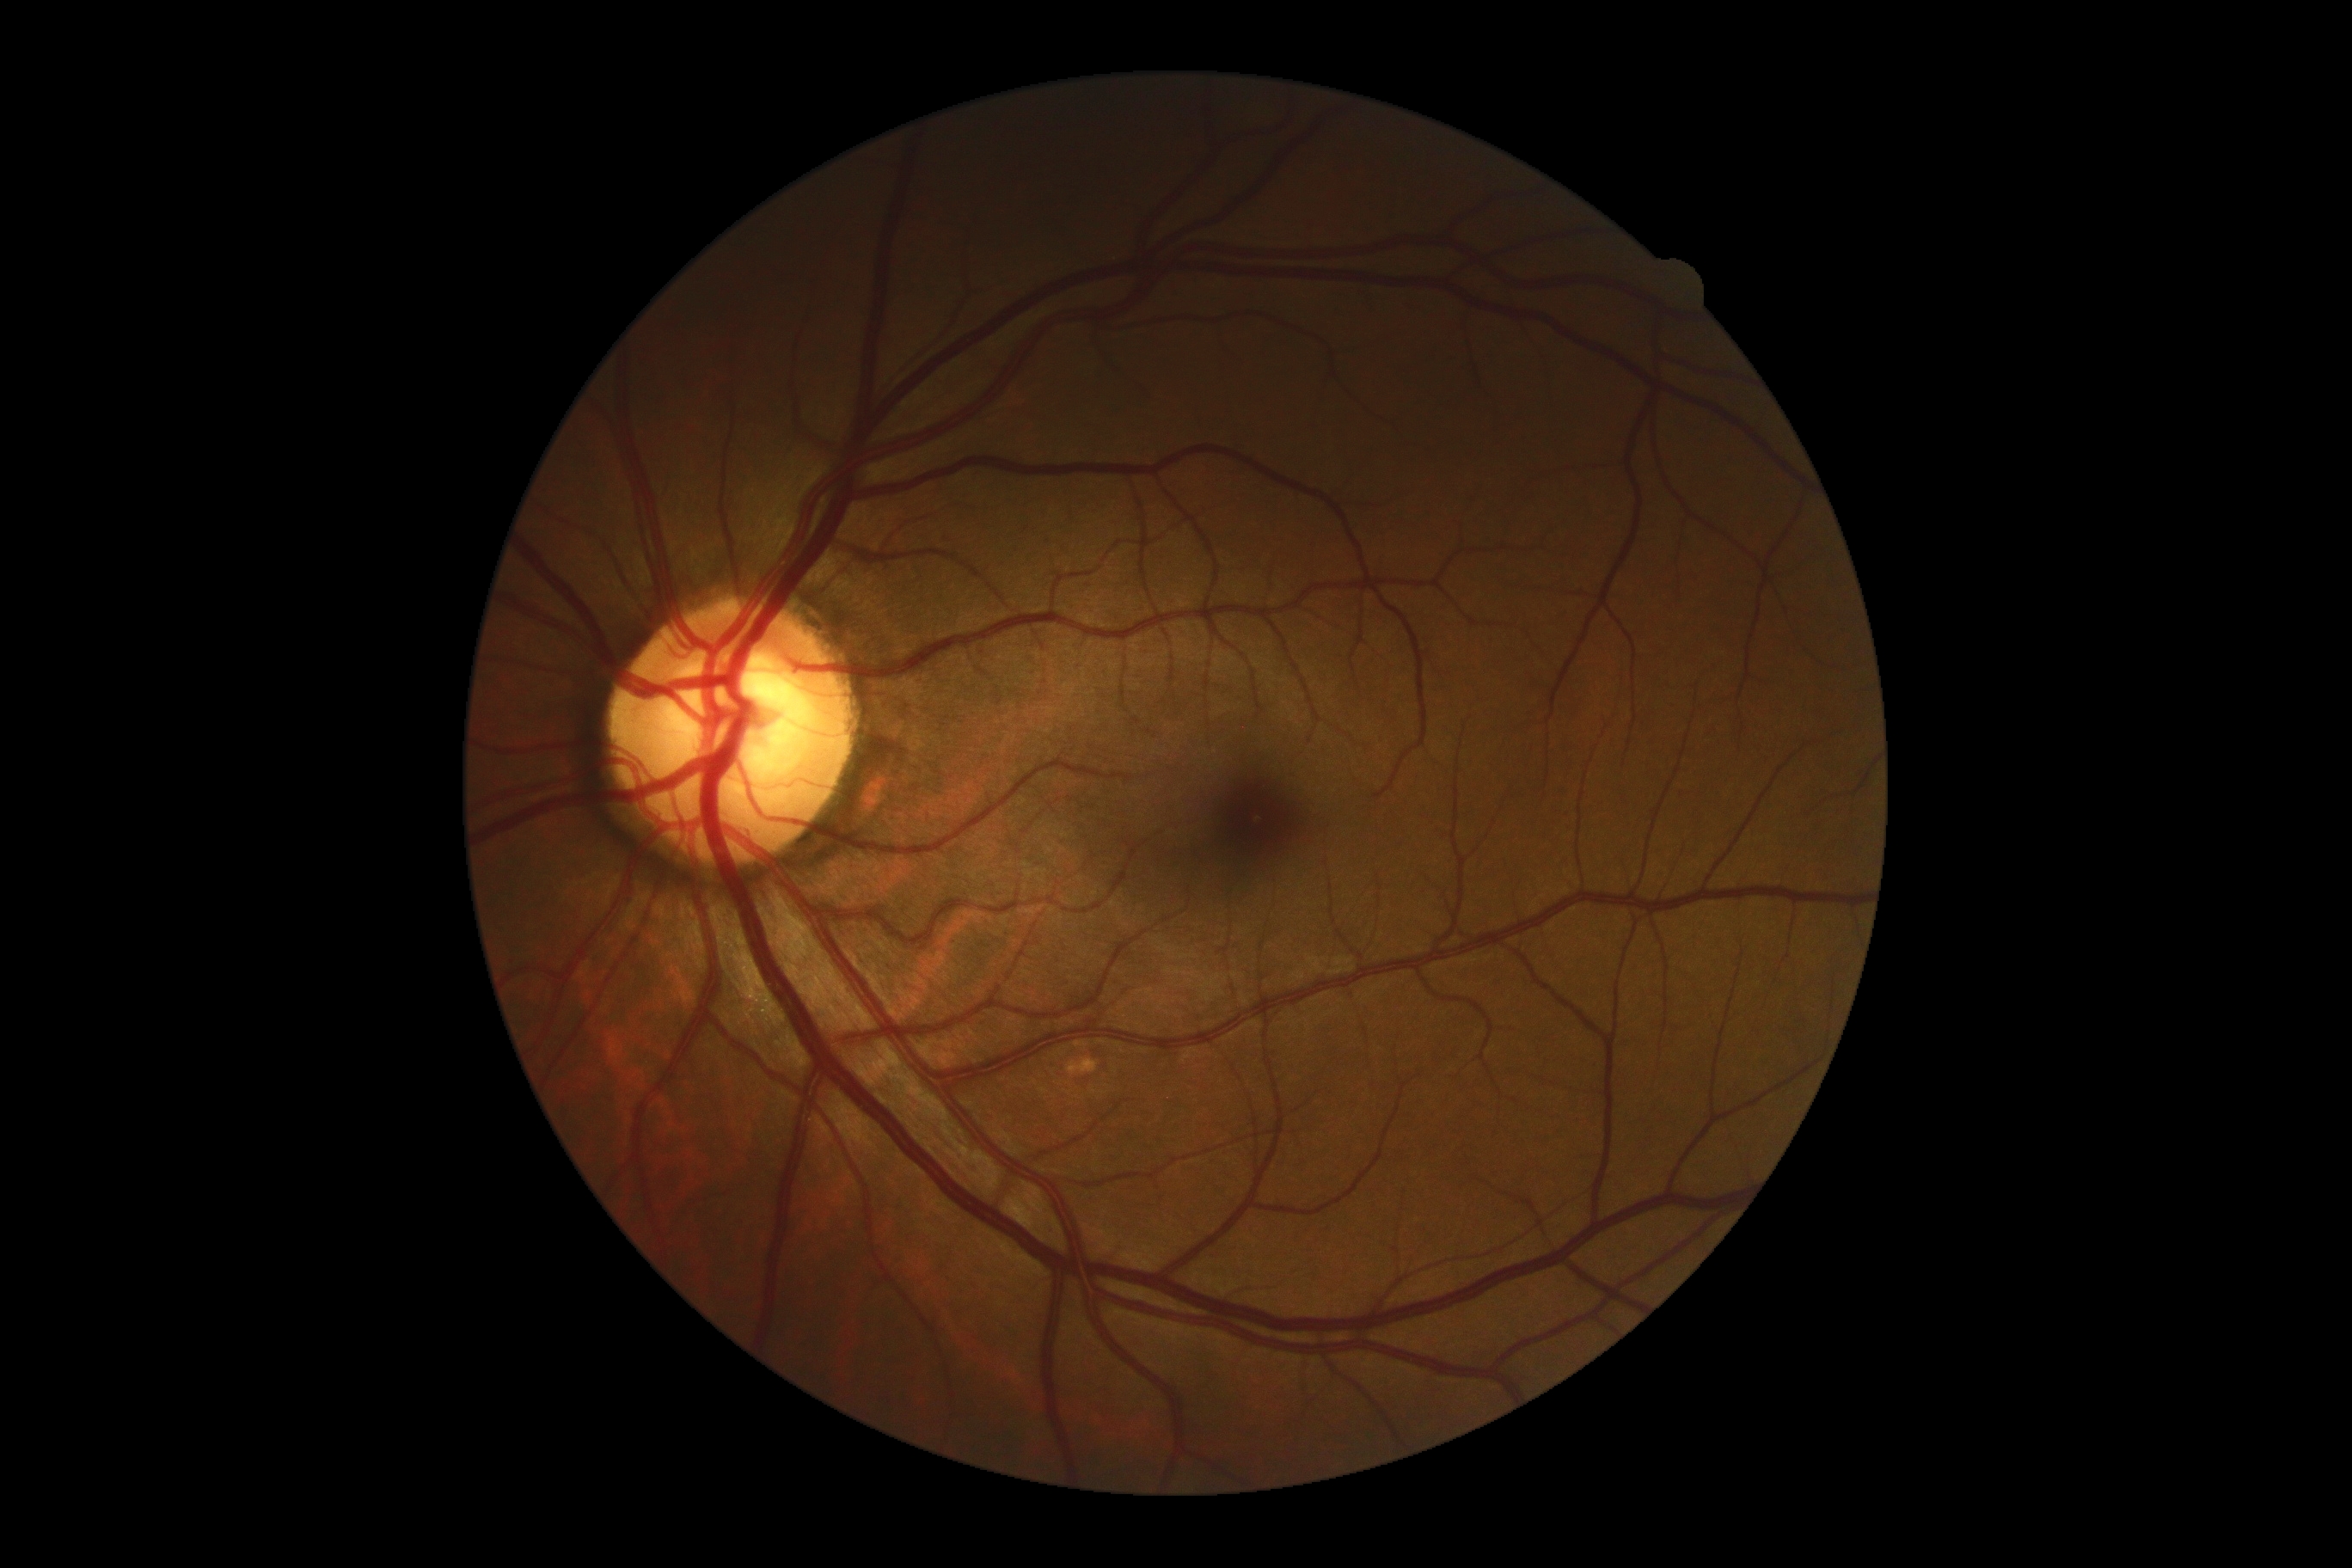

DR: 0/4.